Captured on a Topcon TRC-NW8 fundus camera; 50° FOV.
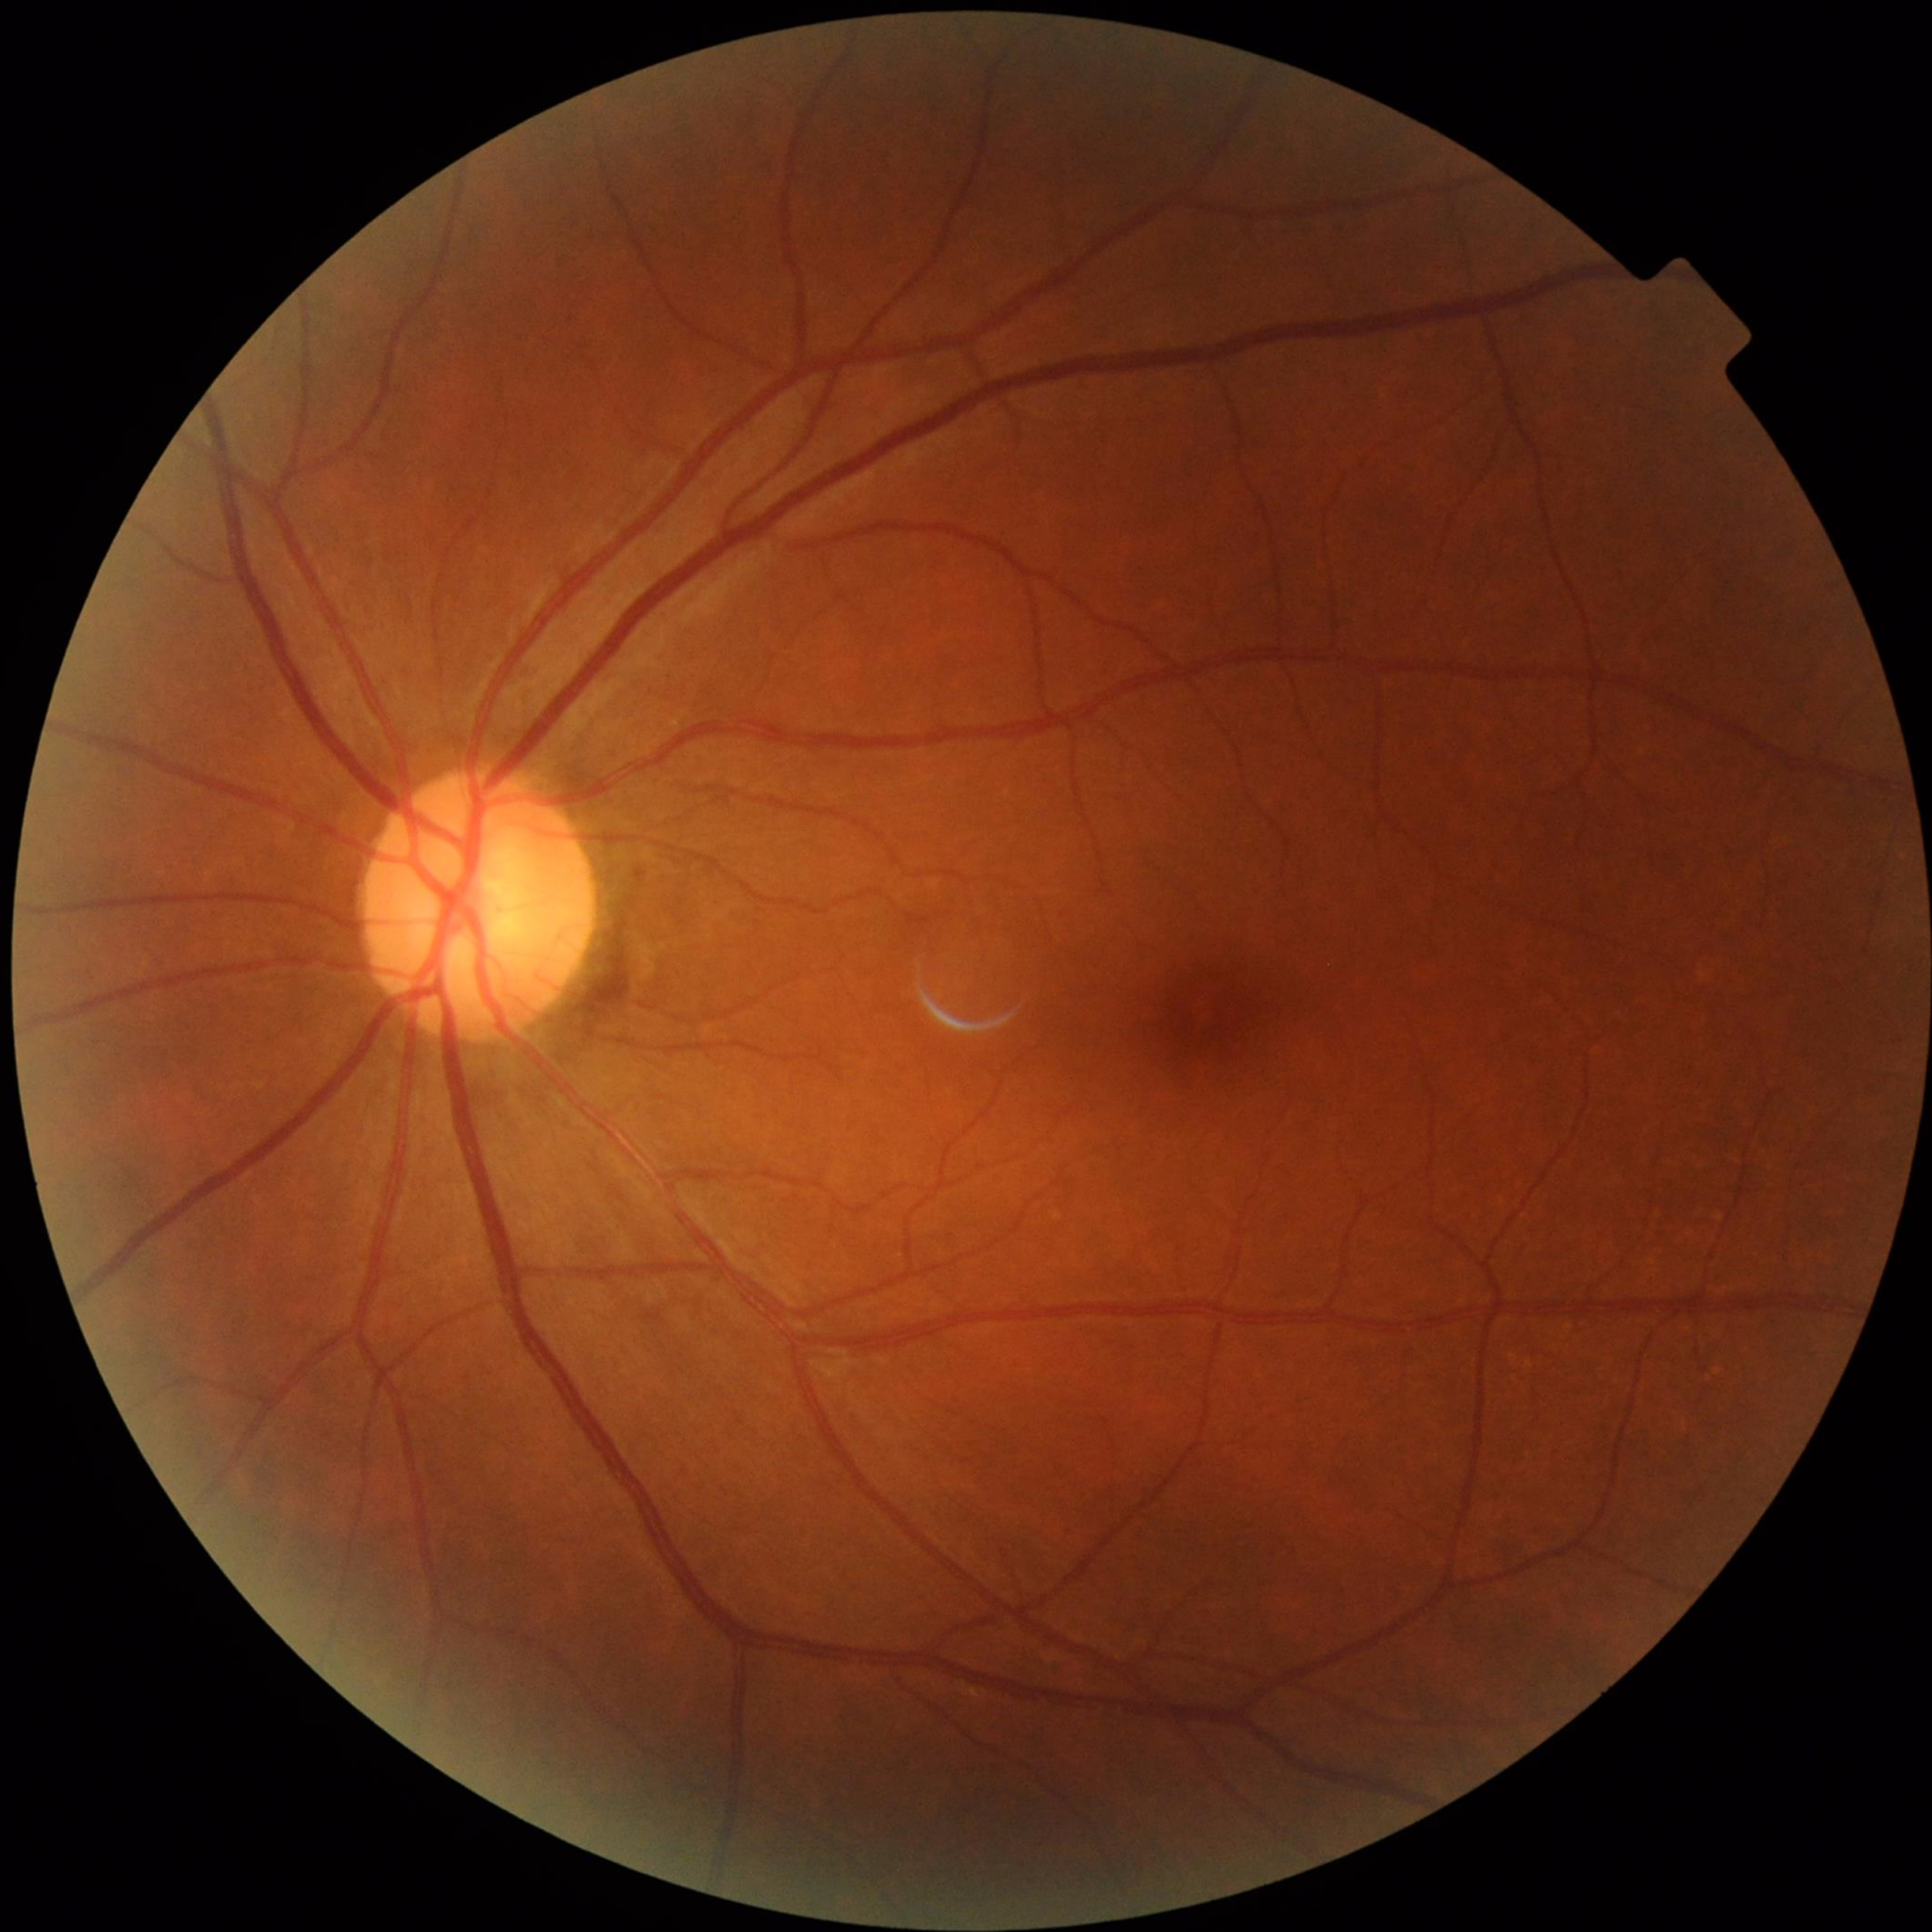 Color fundus photo from a control patient without diagnosed retinal disease.